Nonmydriatic fundus photograph · modified Davis grading · NIDEK AFC-230 fundus camera · 45 degree fundus photograph.
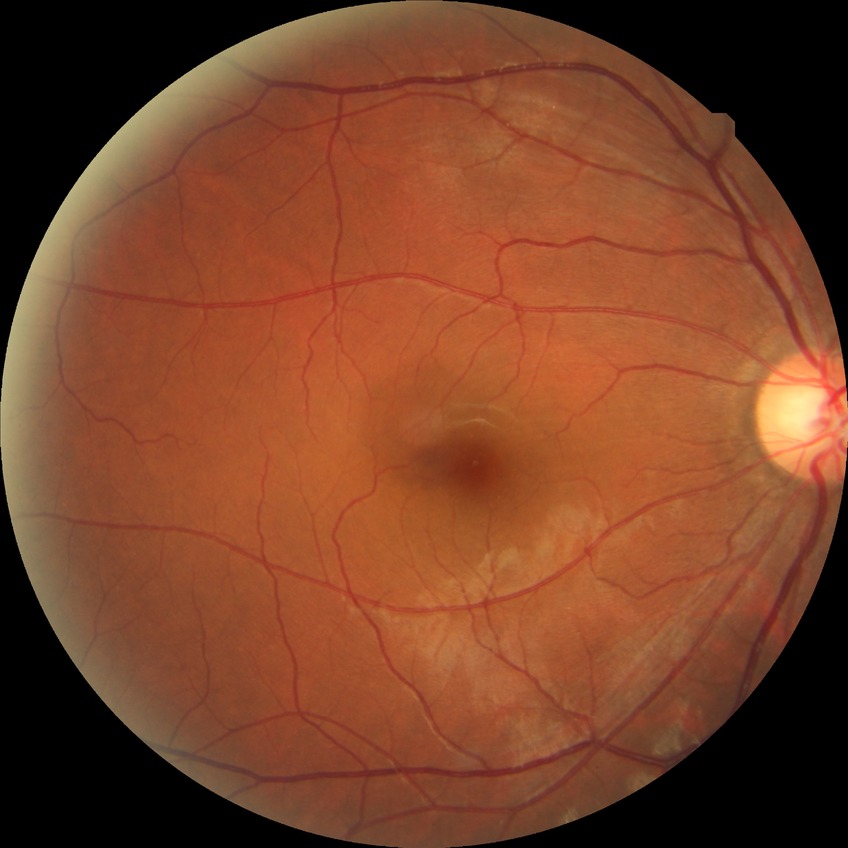

Diabetic retinopathy (DR): NDR (no diabetic retinopathy).